CFP — 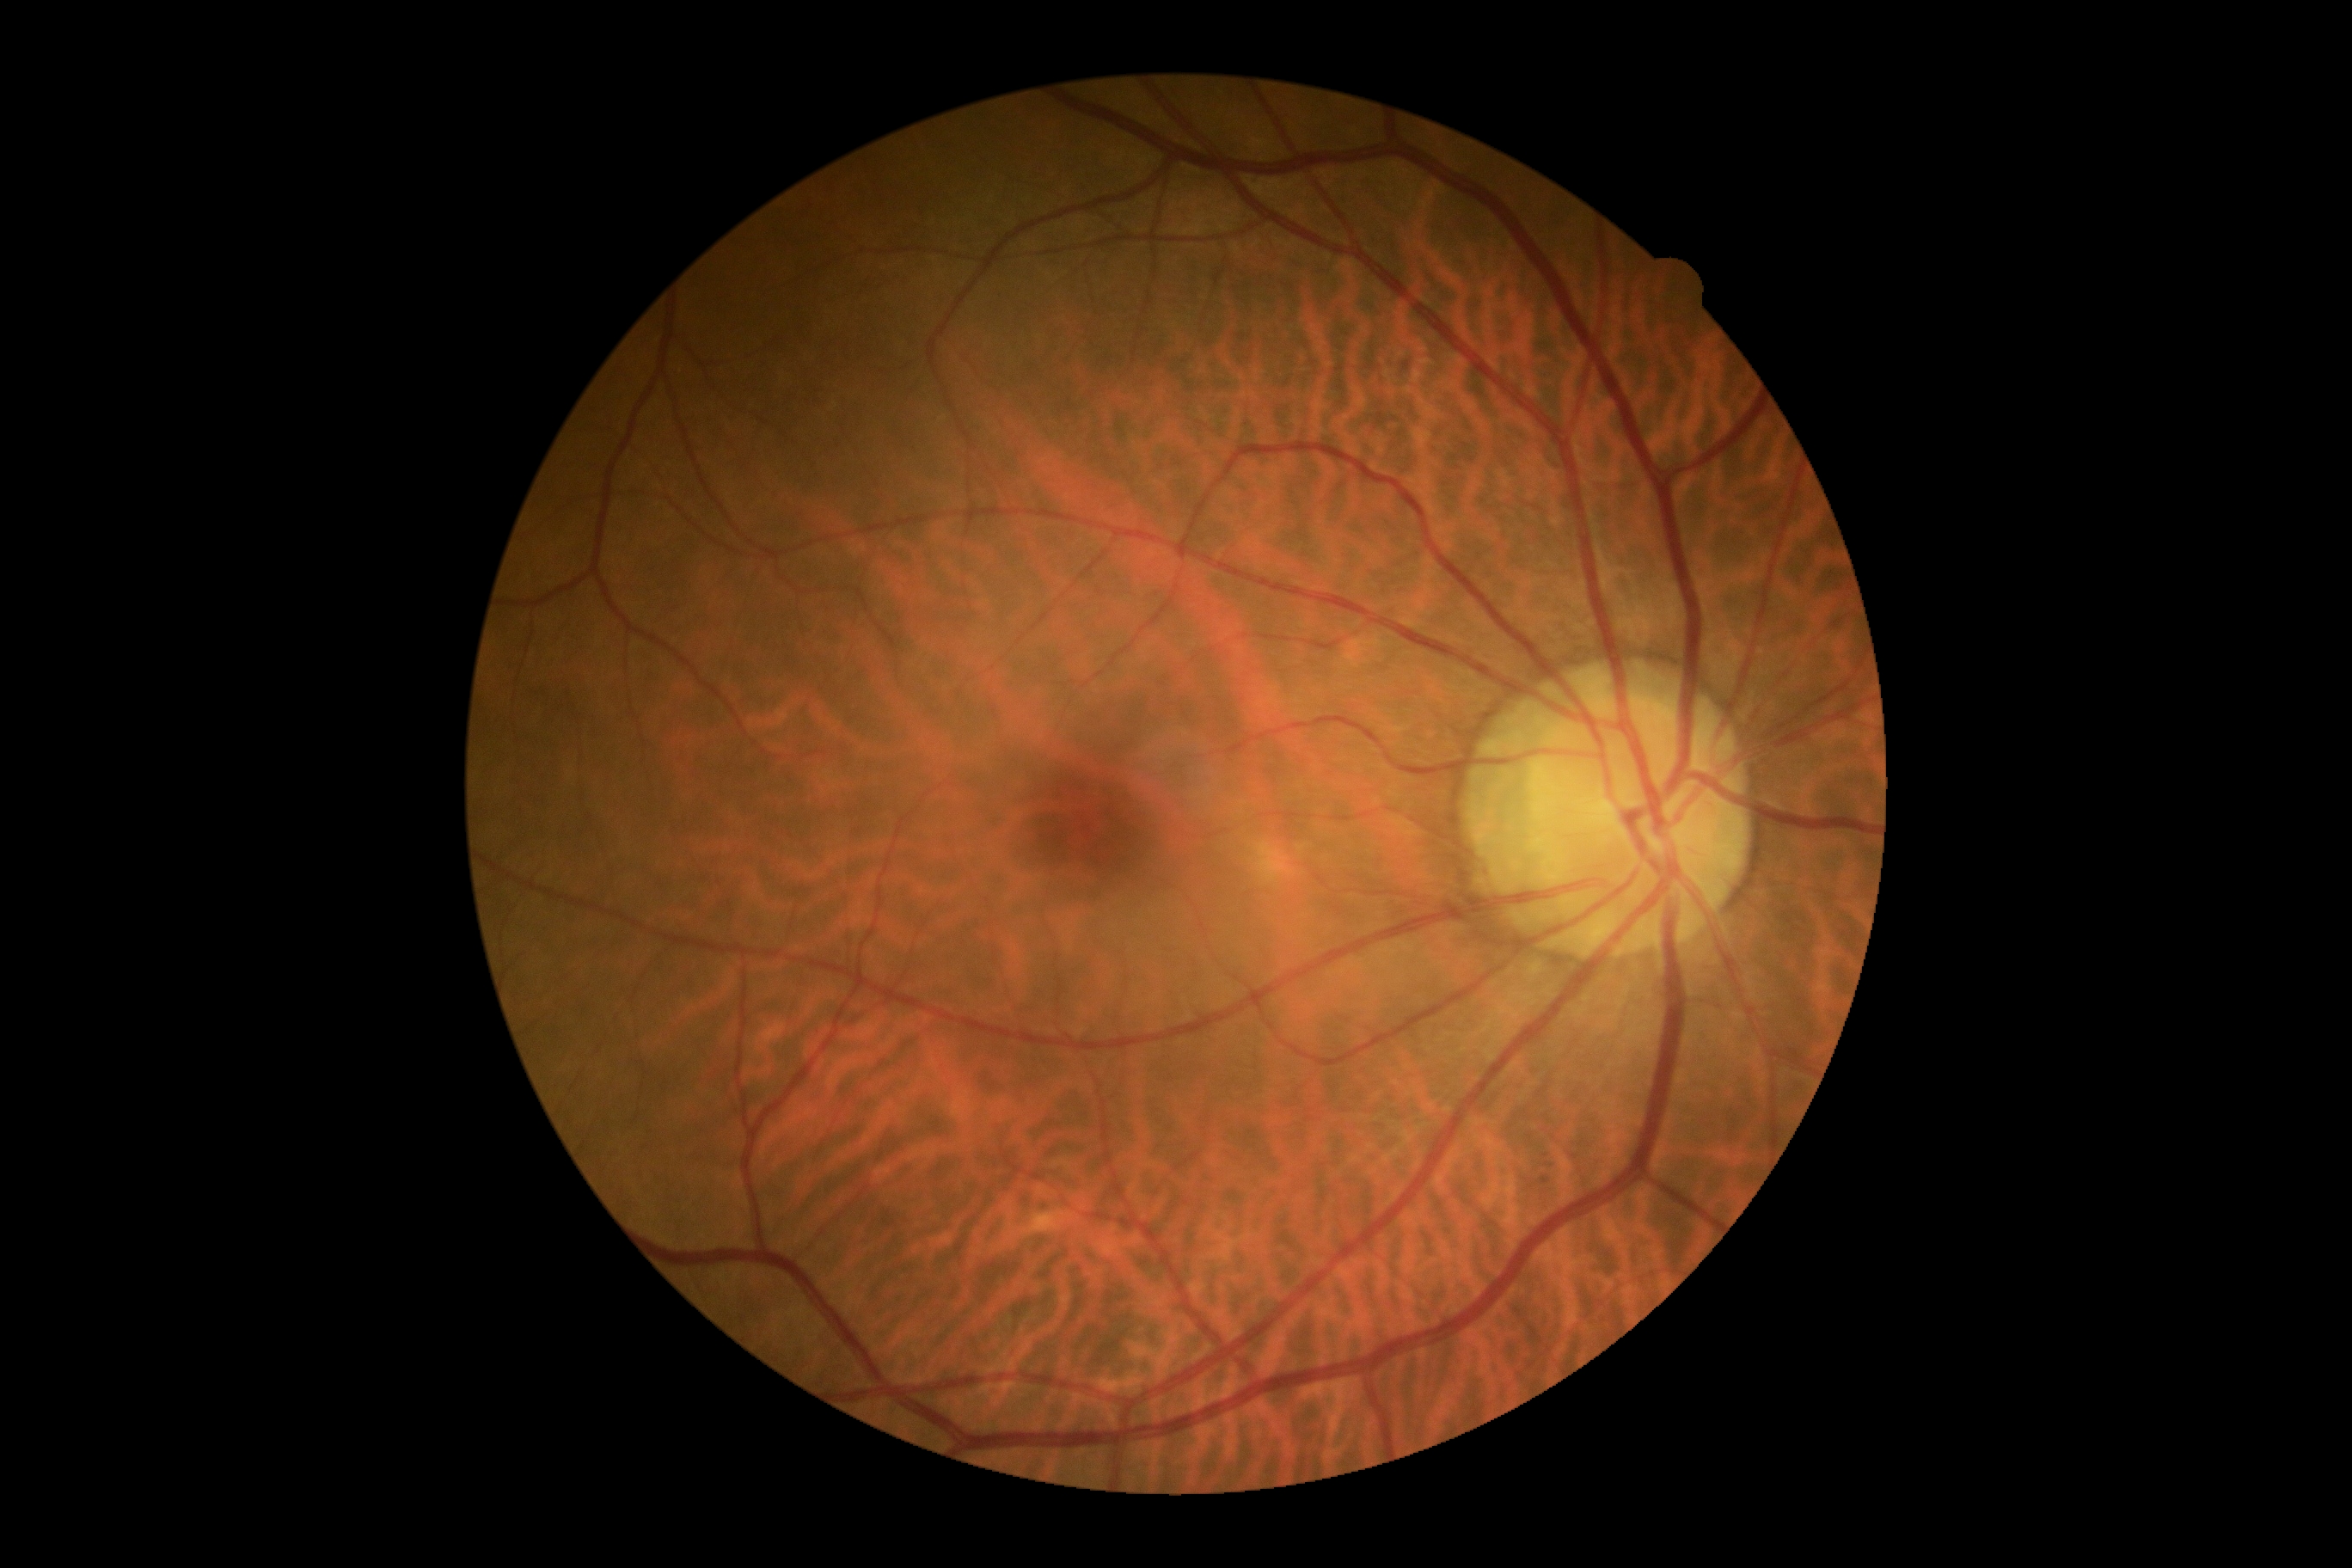
– retinopathy grade: 0 — no visible signs of diabetic retinopathy